2352 by 1568 pixels, 45° field of view.
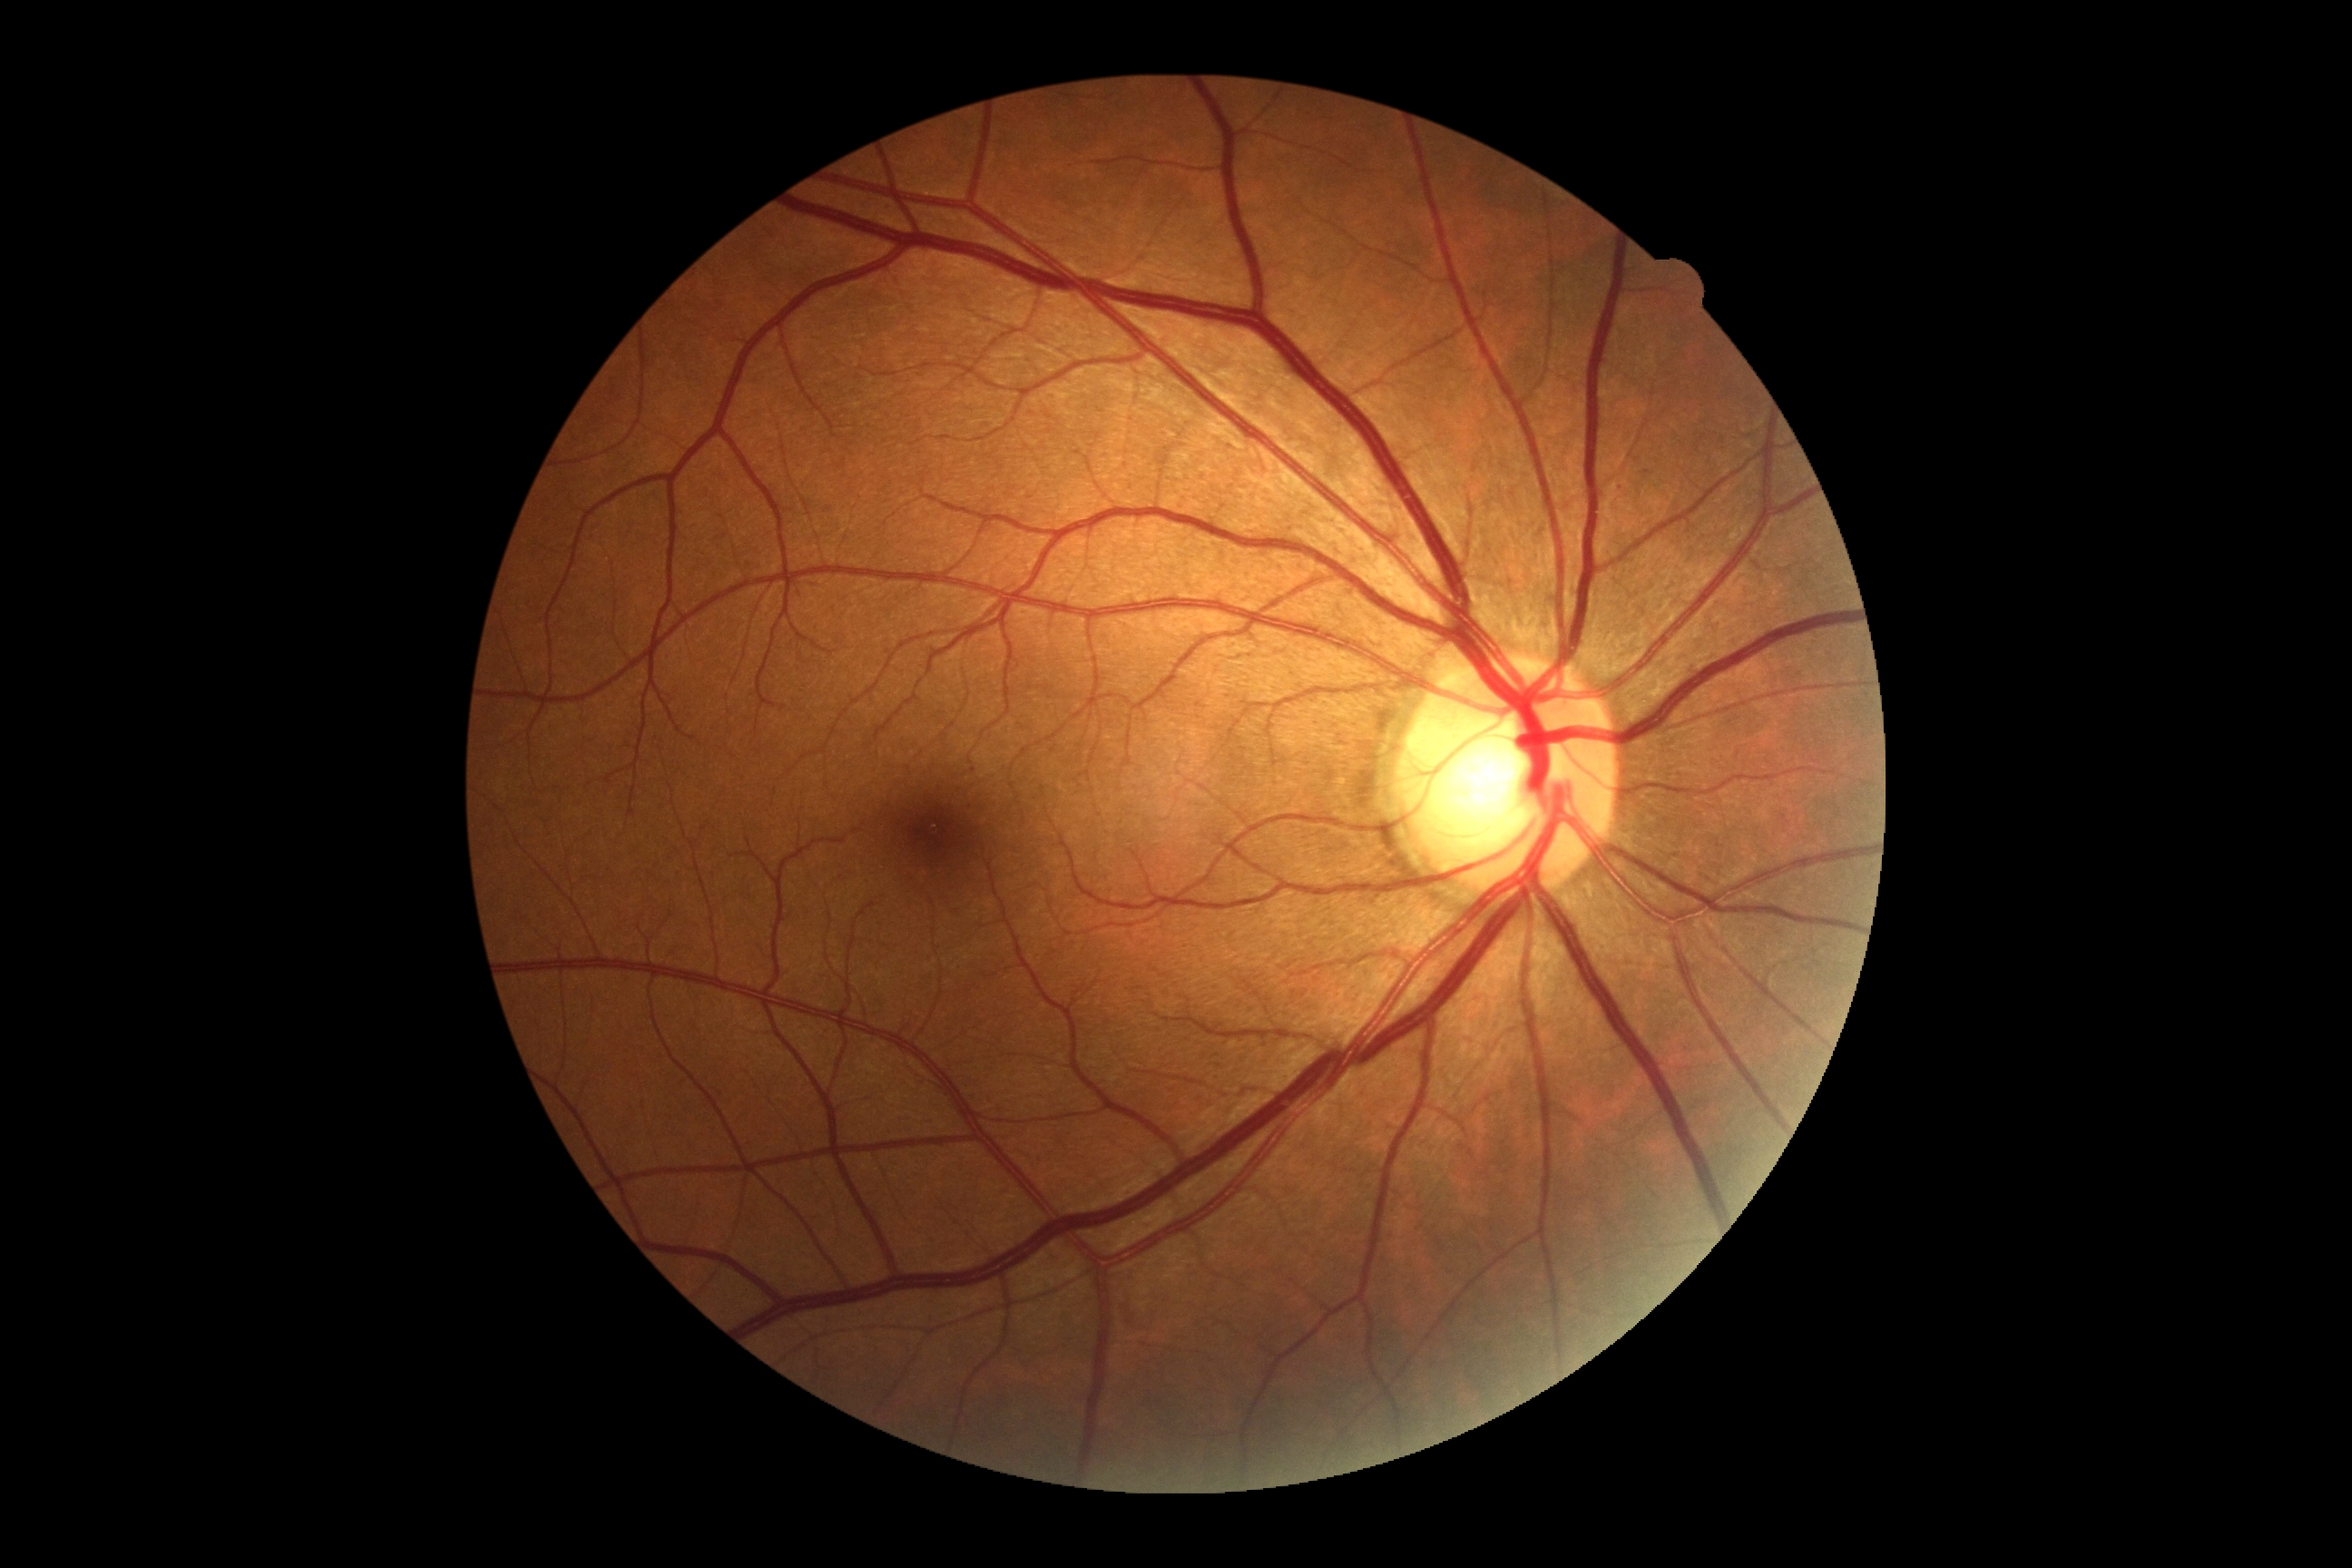

No apparent diabetic retinopathy. Diabetic retinopathy (DR) is no apparent retinopathy (grade 0).